2352 by 1568 pixels.
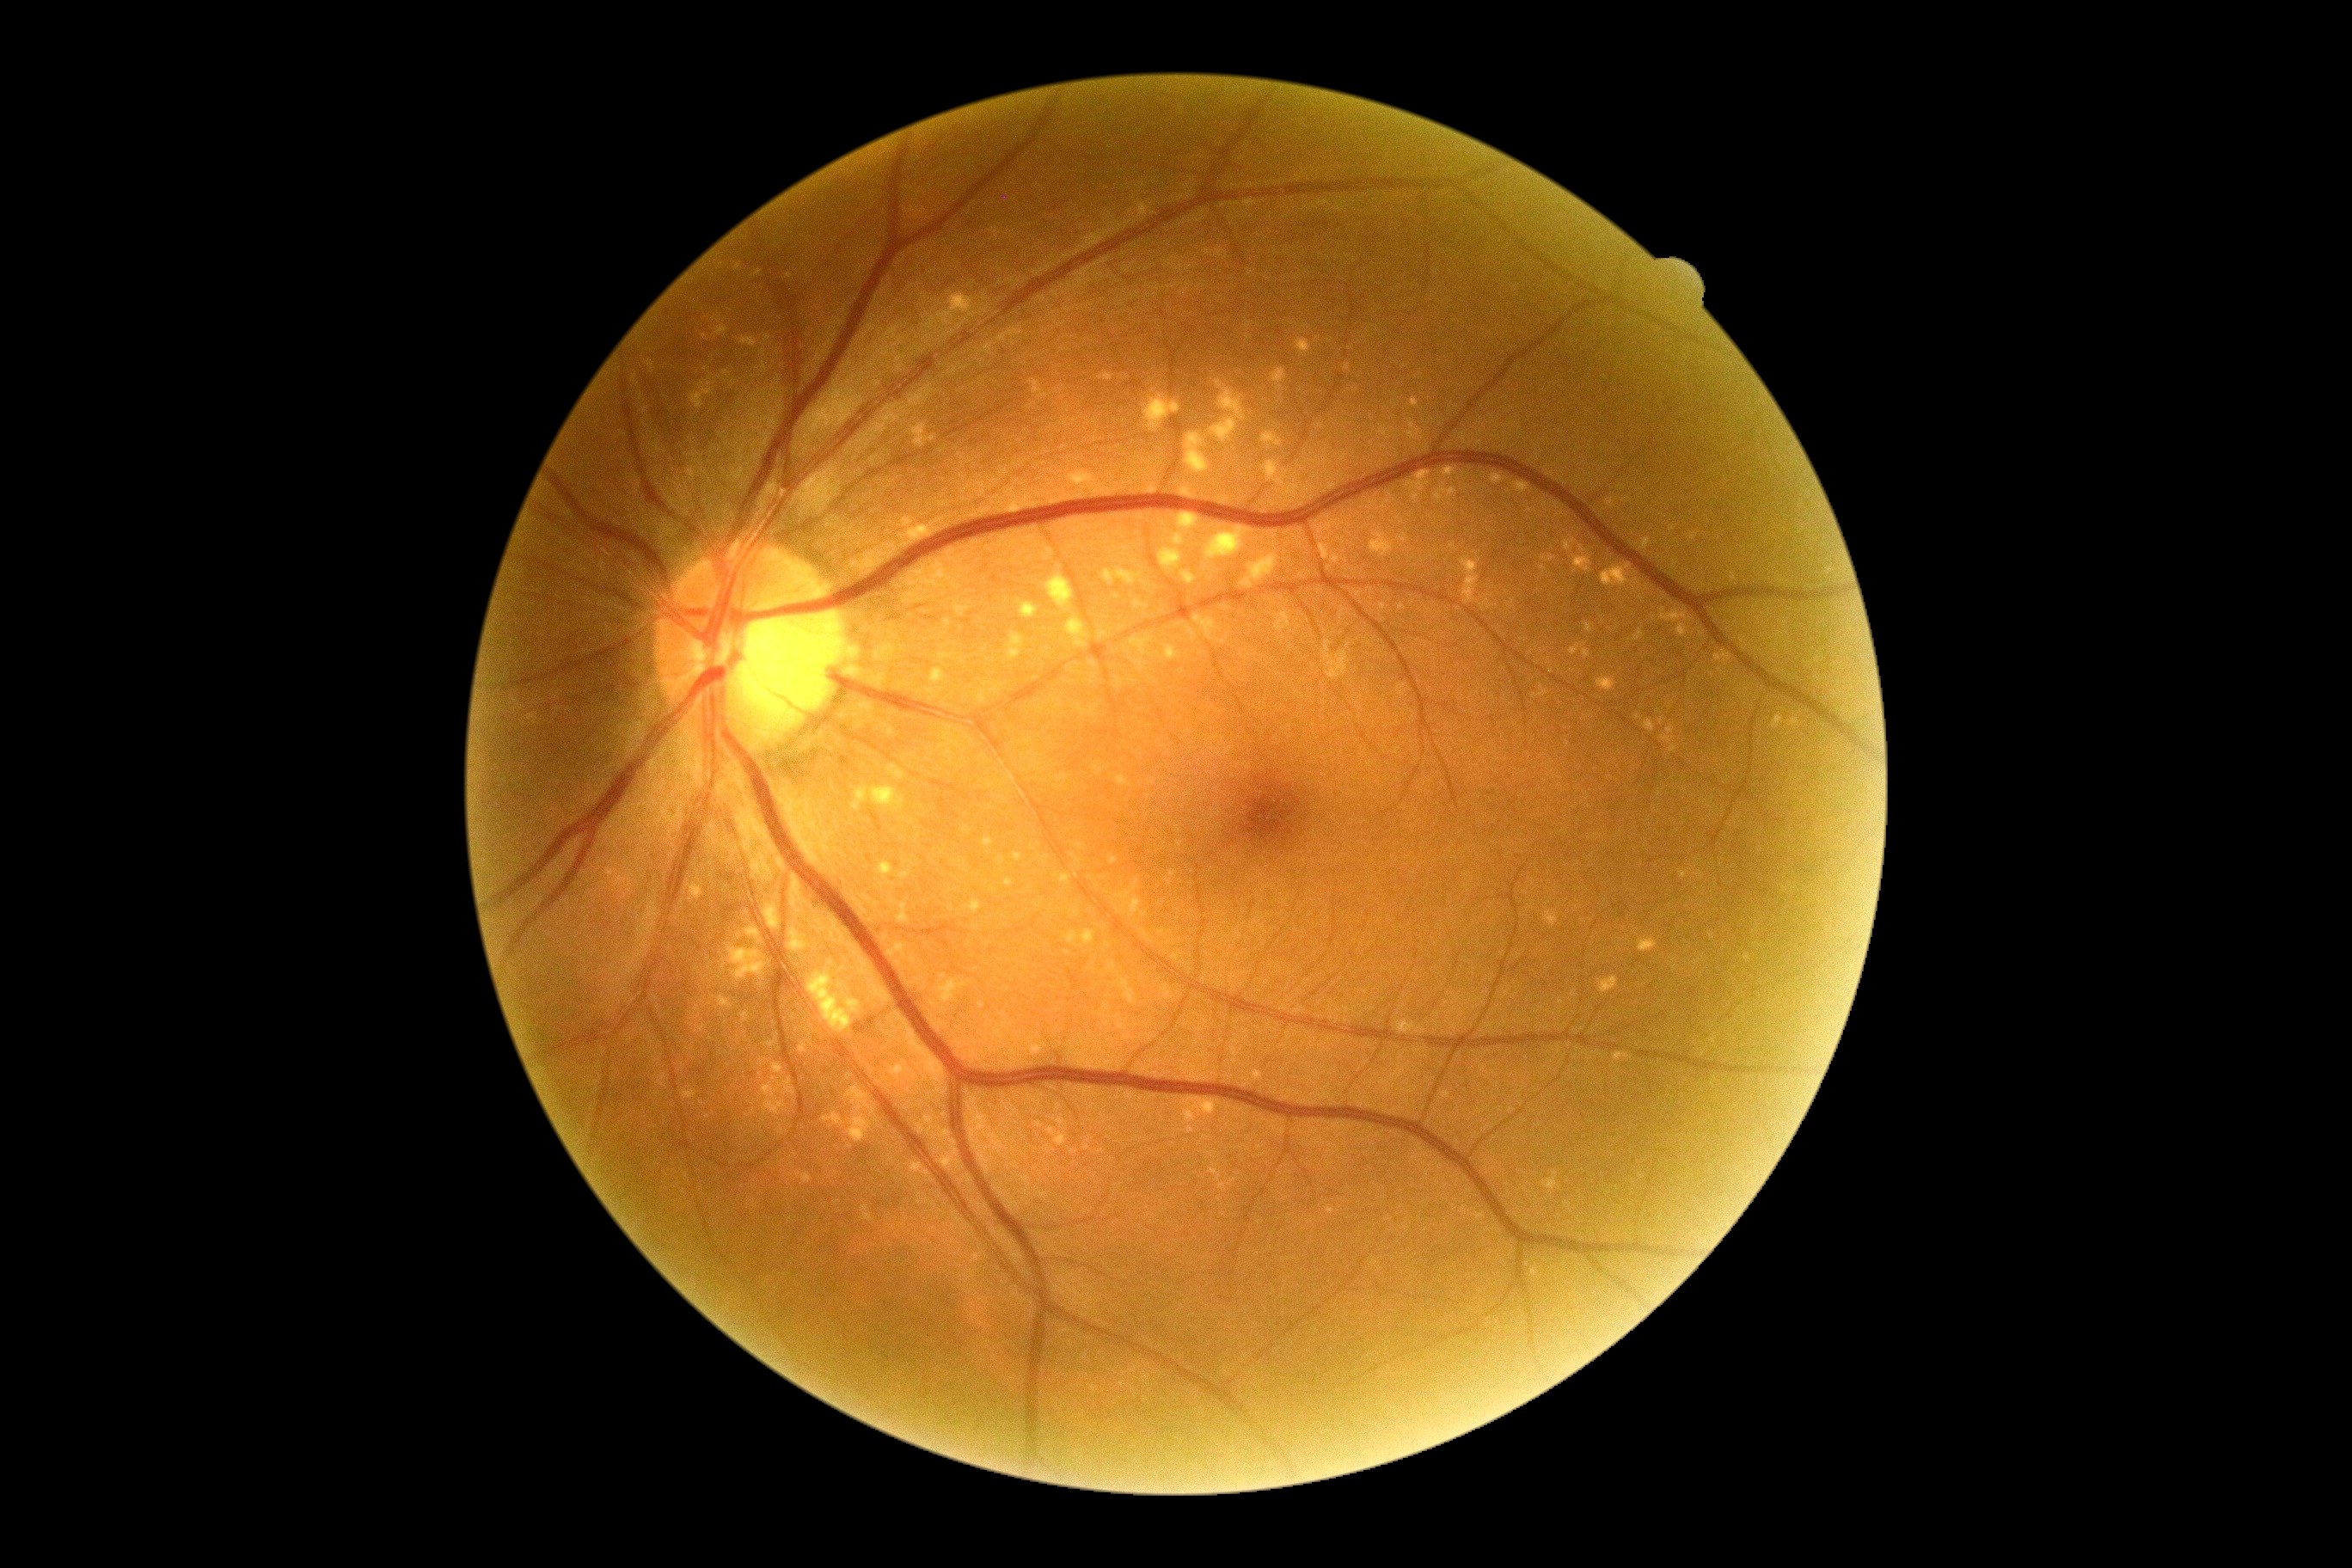

DR is grade 0.